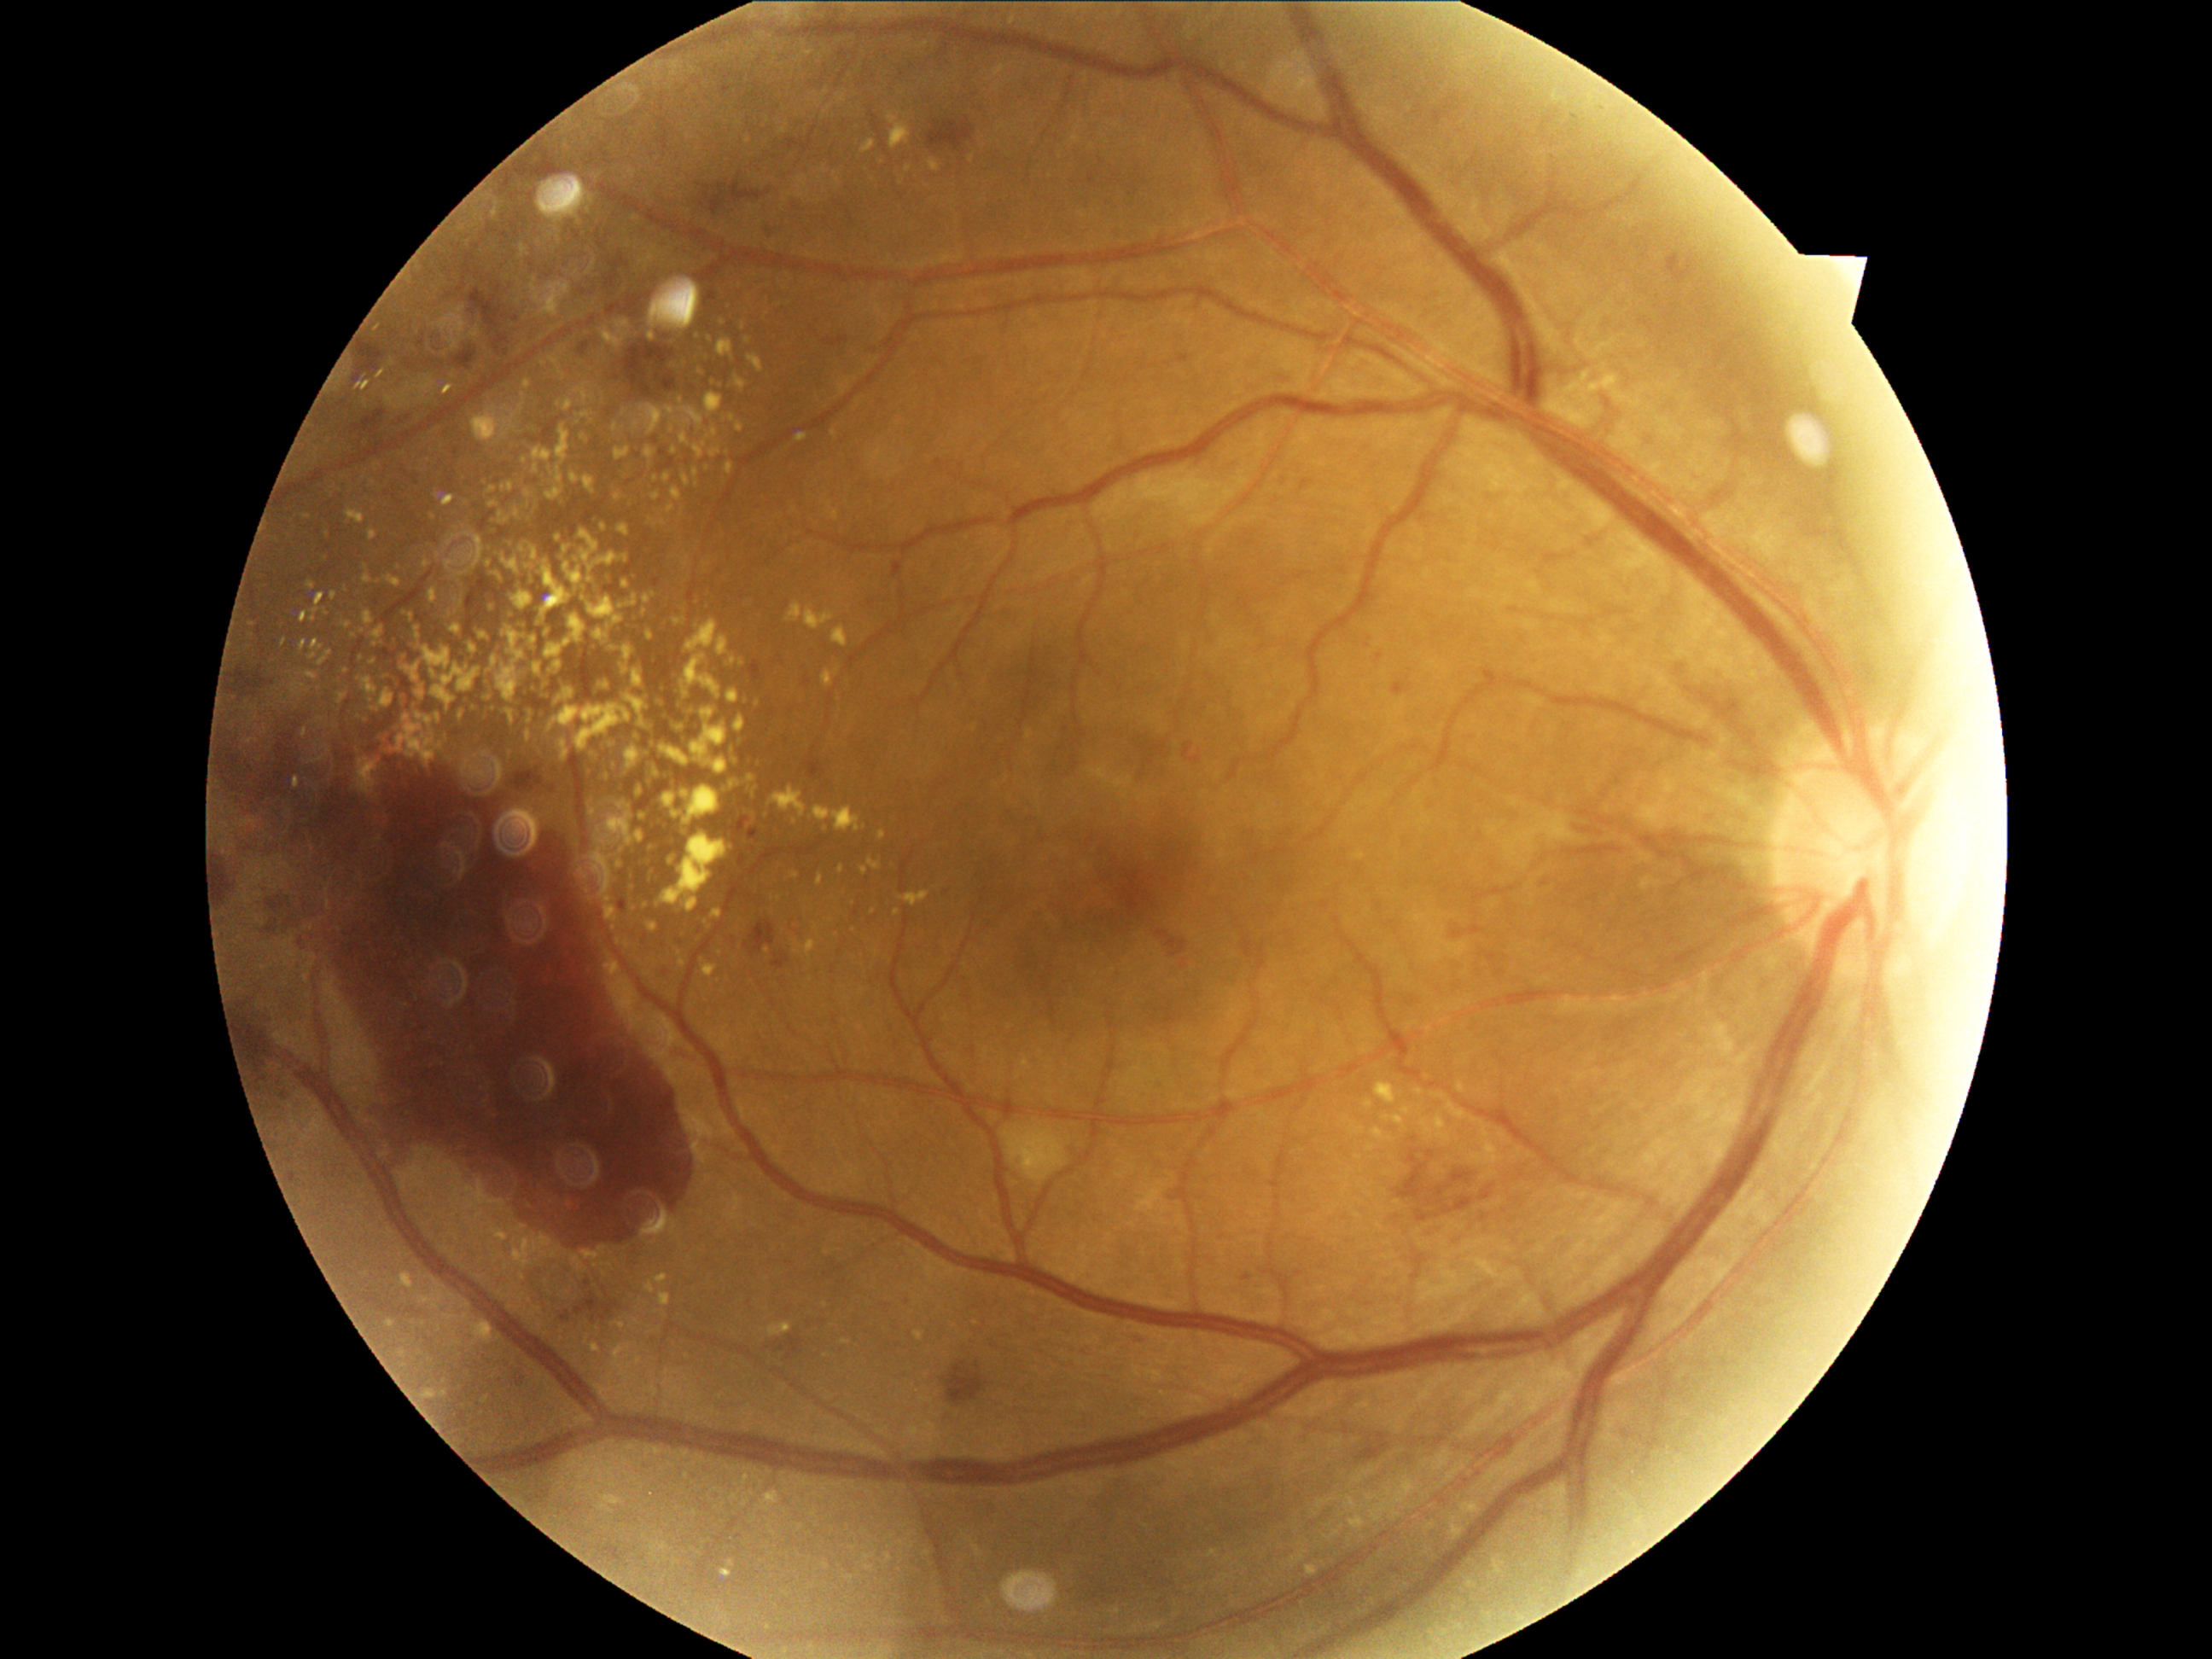

Diabetic retinopathy grade is 4
Lesions identified (partial list):
- hard exudates (continued): [501,629,525,661] | [378,643,385,653] | [602,643,619,653] | [545,631,549,643] | [557,689,576,702] | [736,380,747,390] | [381,742,388,750] | [614,1344,631,1366] | [684,690,690,699] | [1307,1566,1317,1575] | [400,699,405,707] | [422,1390,436,1400]
- Additional small hard exudates near 439/747 | 897/913 | 426/565 | 492/490 | 652/337 | 797/875 | 837/514